1240x1240px · Phoenix ICON, 100° FOV · wide-field contact fundus photograph of an infant:
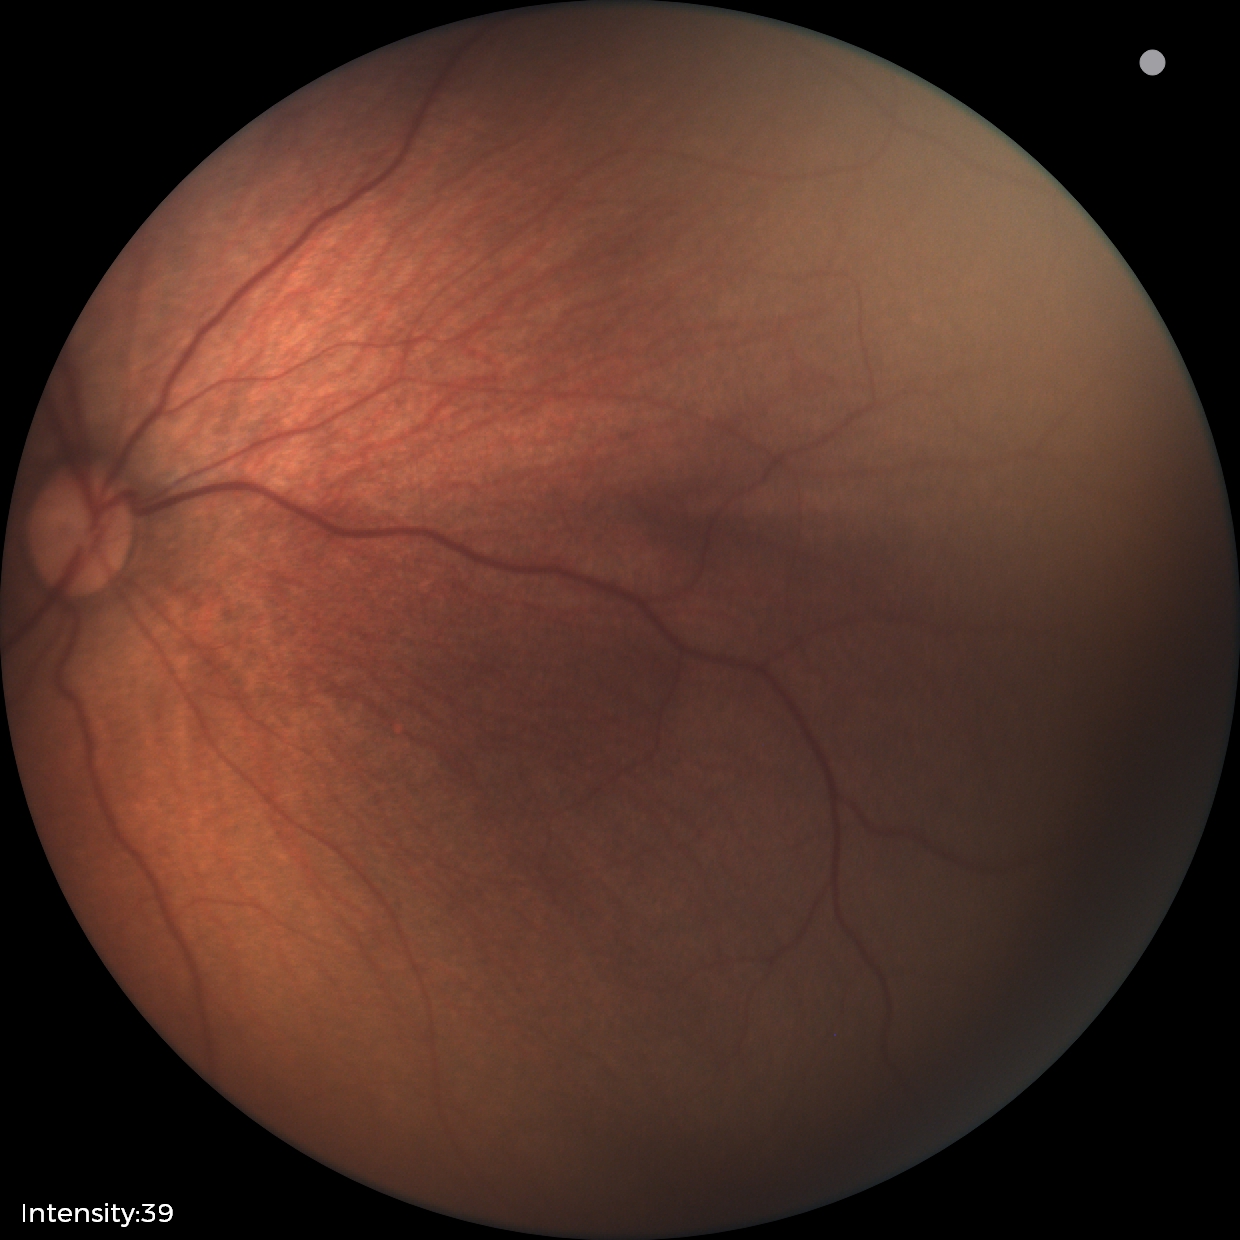
Physiological retinal appearance for postconceptual age.